45° field of view:
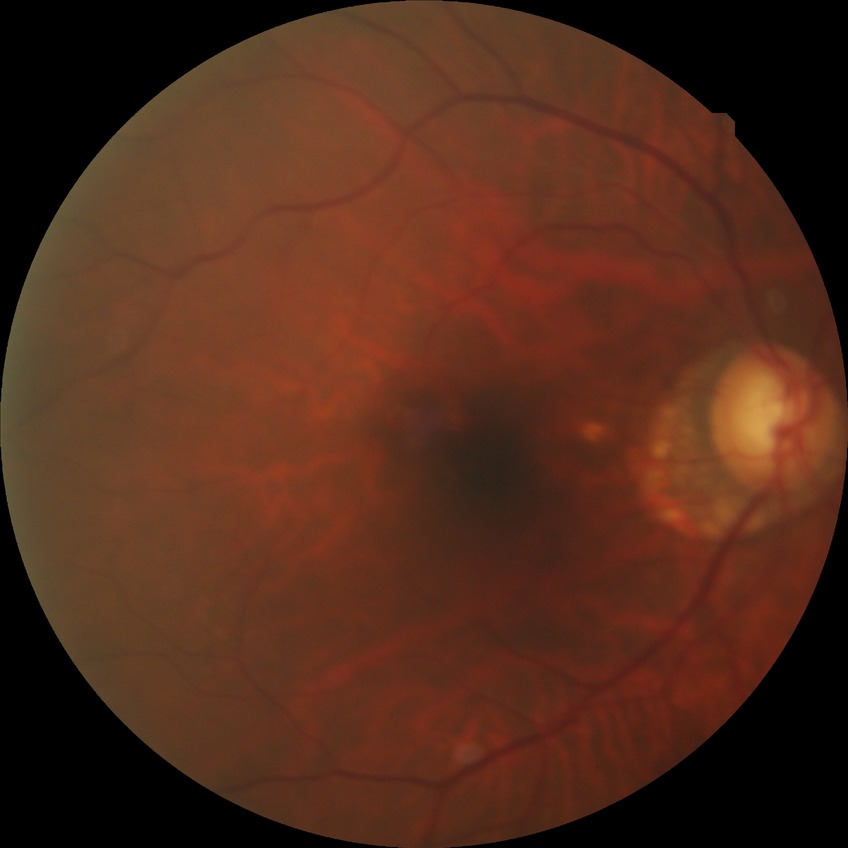
Diabetic retinopathy (DR): no diabetic retinopathy (NDR).